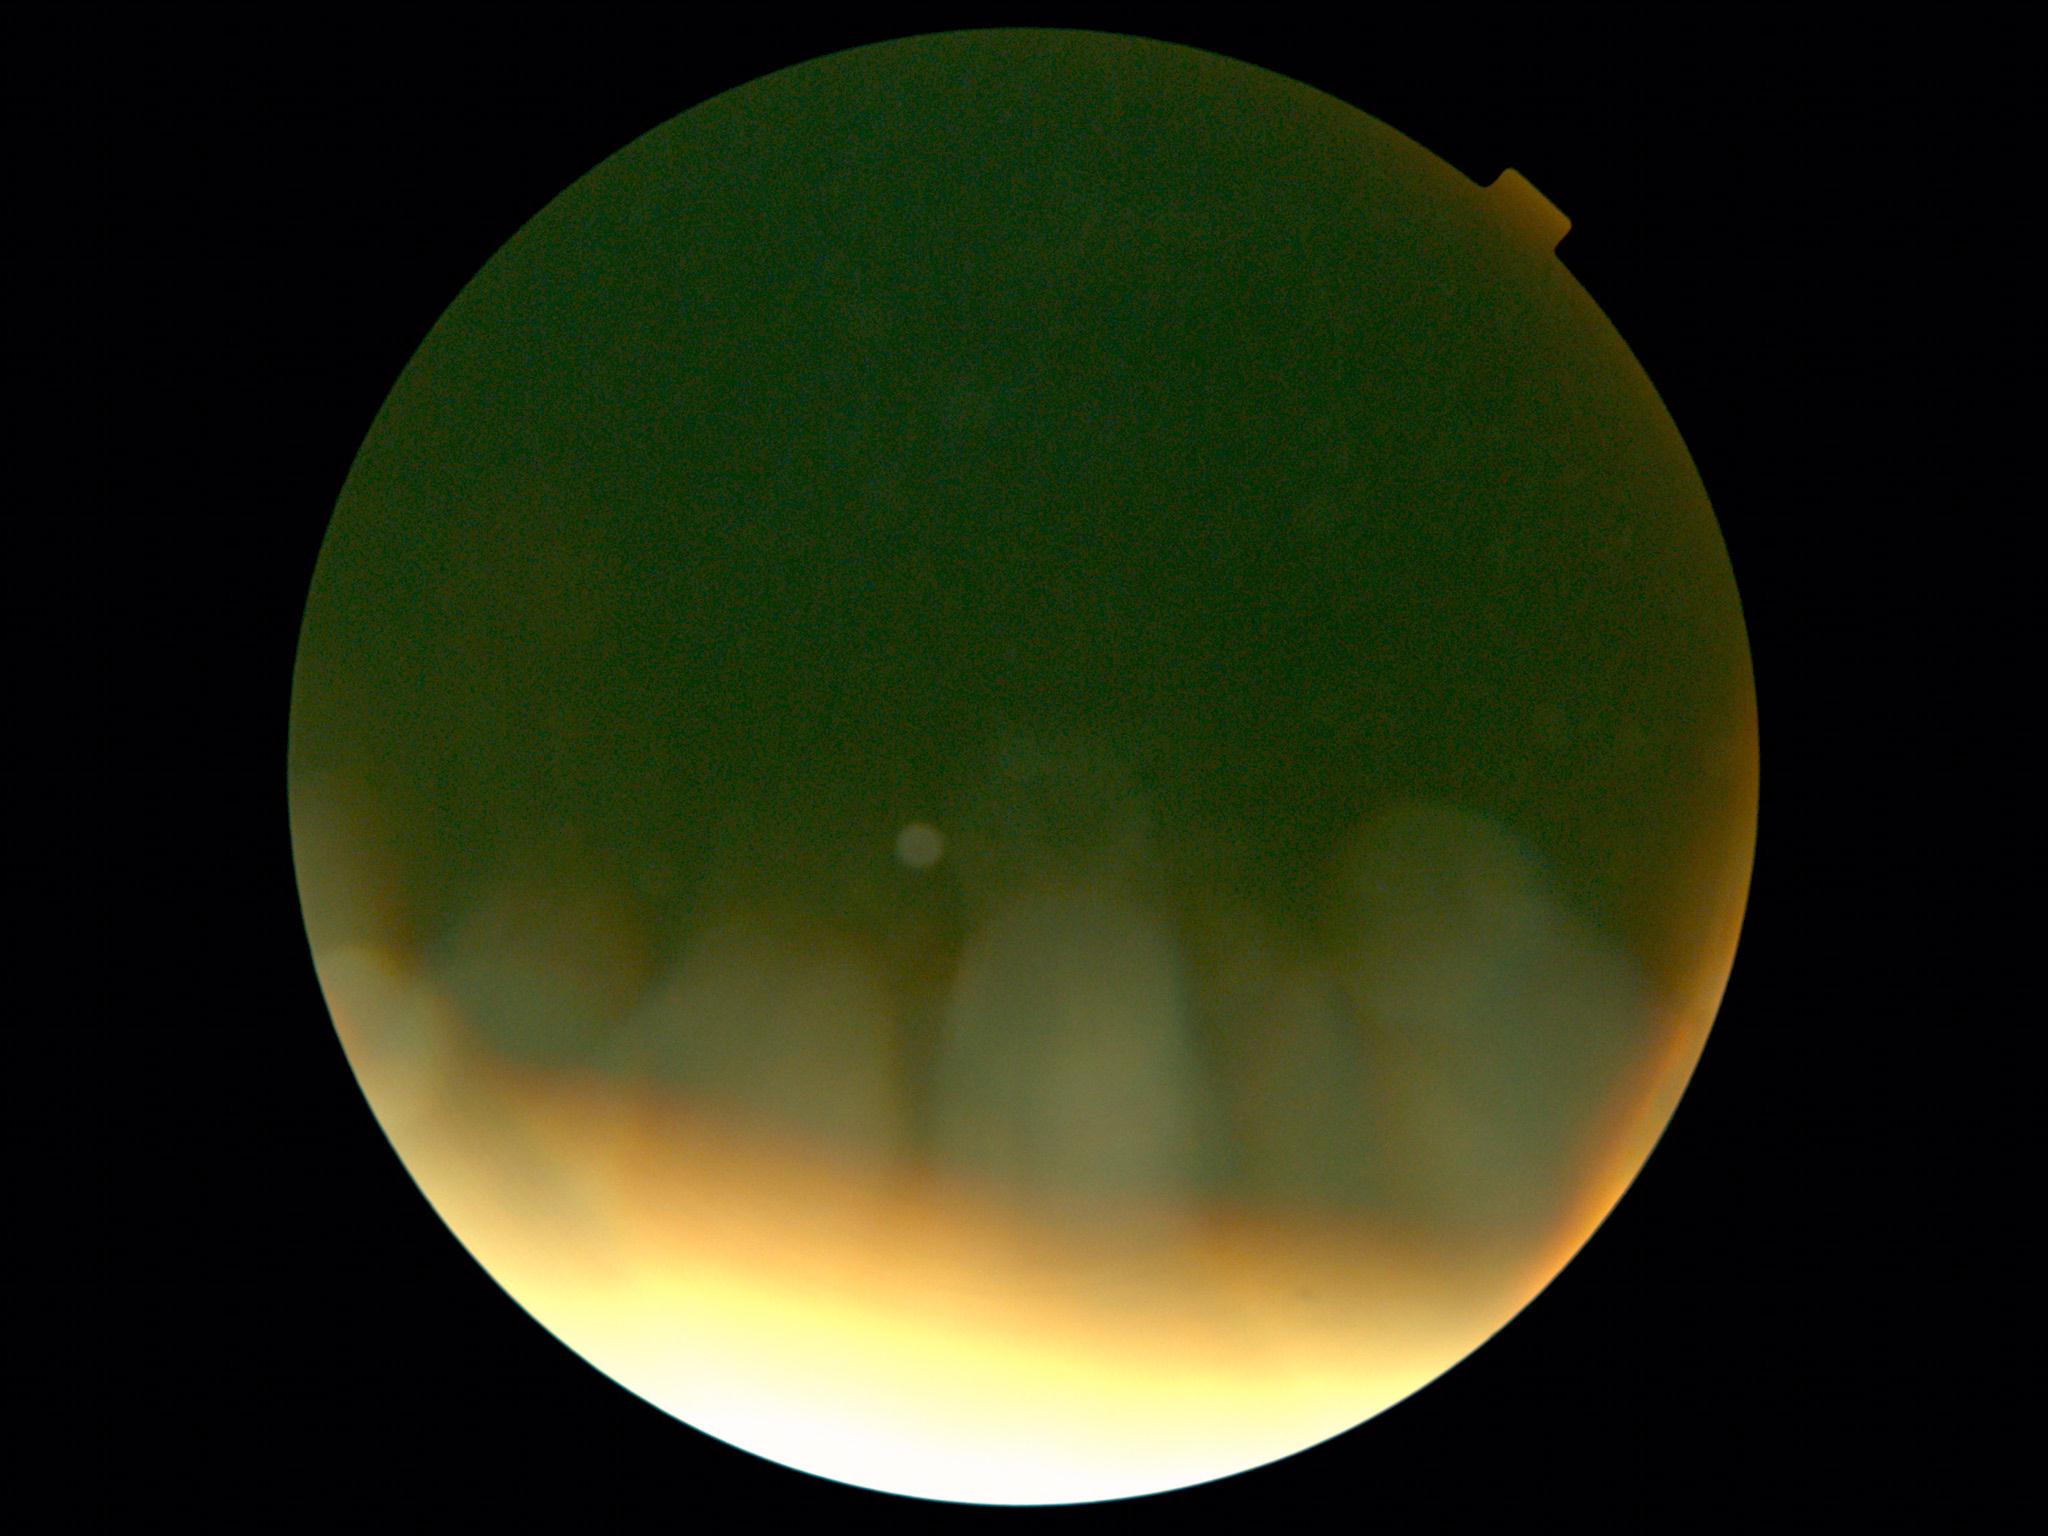
retinopathy grade = ungradable.